Posterior pole color fundus photograph — 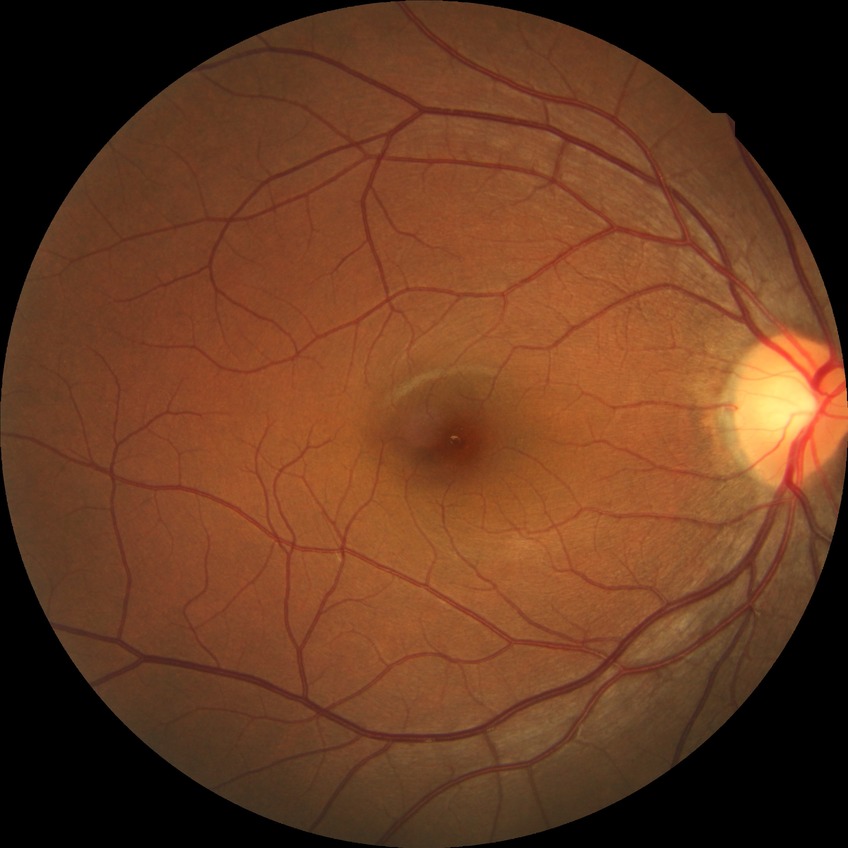

davis_grade: NDR (no diabetic retinopathy)